1240x1240px; pediatric retinal photograph (wide-field) — 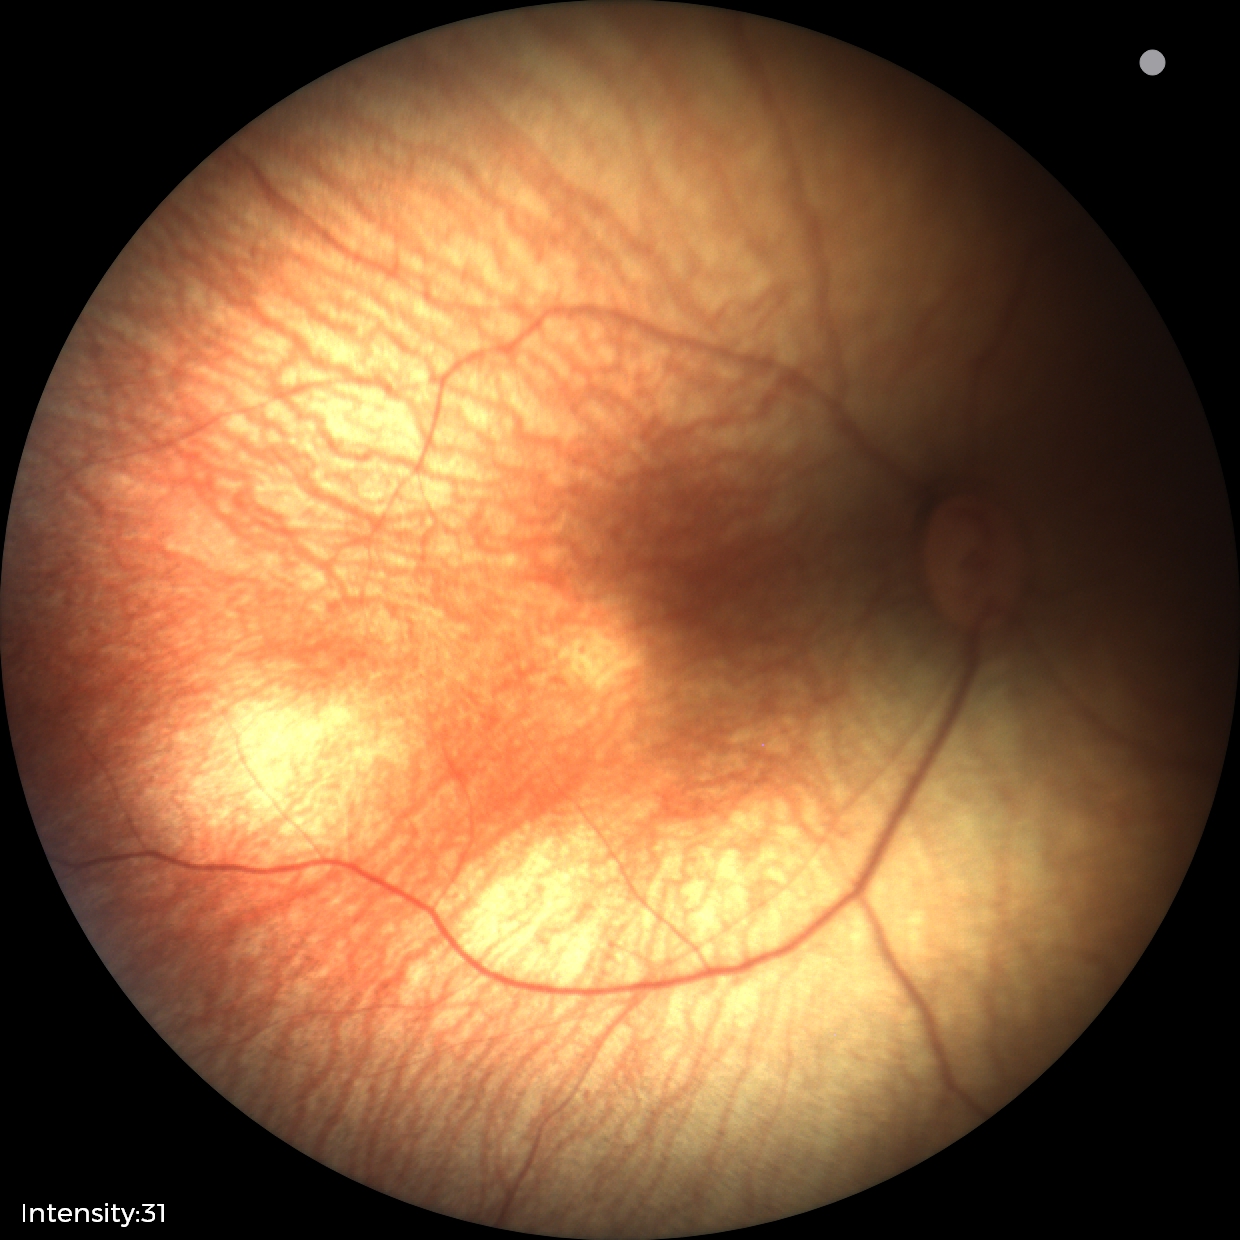 Normal screening examination.